Color fundus photograph:
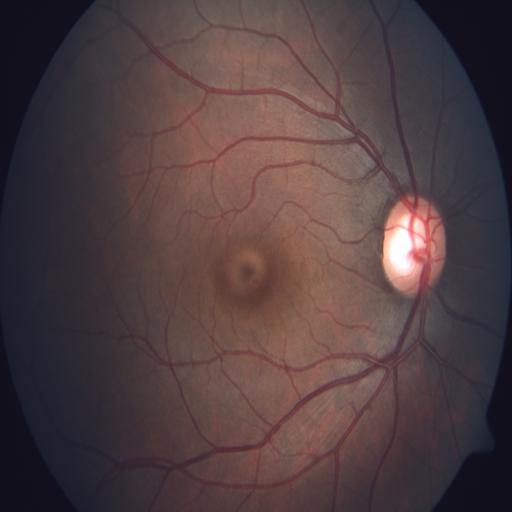

There is evidence of optic disc cupping.